848 by 848 pixels. Modified Davis classification. Camera: NIDEK AFC-230 — 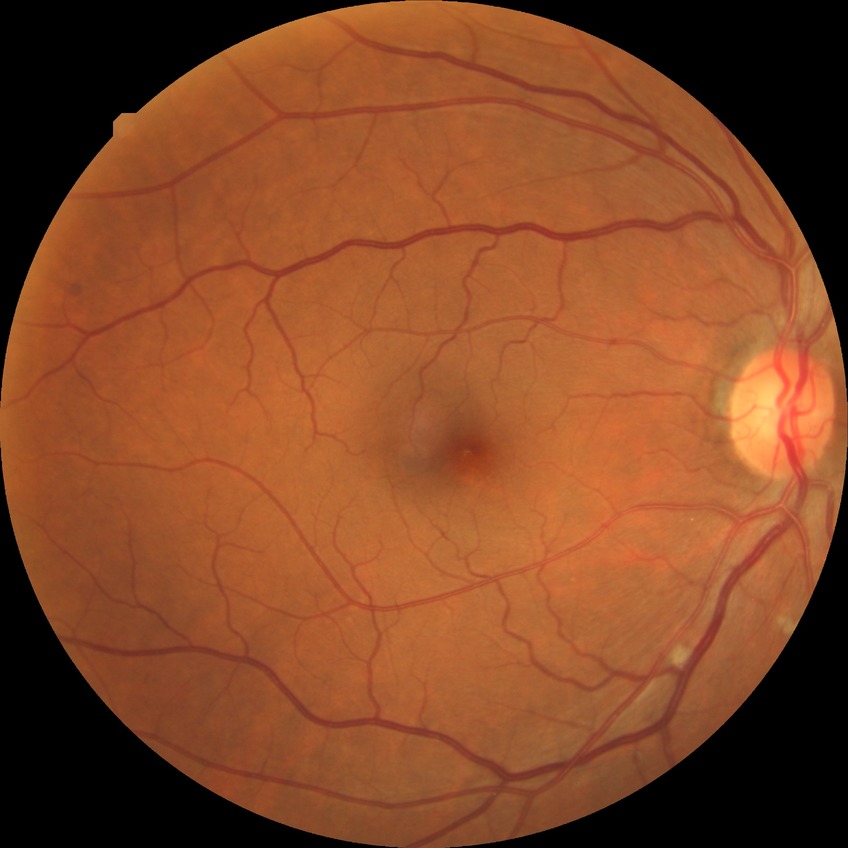
diabetic retinopathy (DR) = no diabetic retinopathy (NDR).